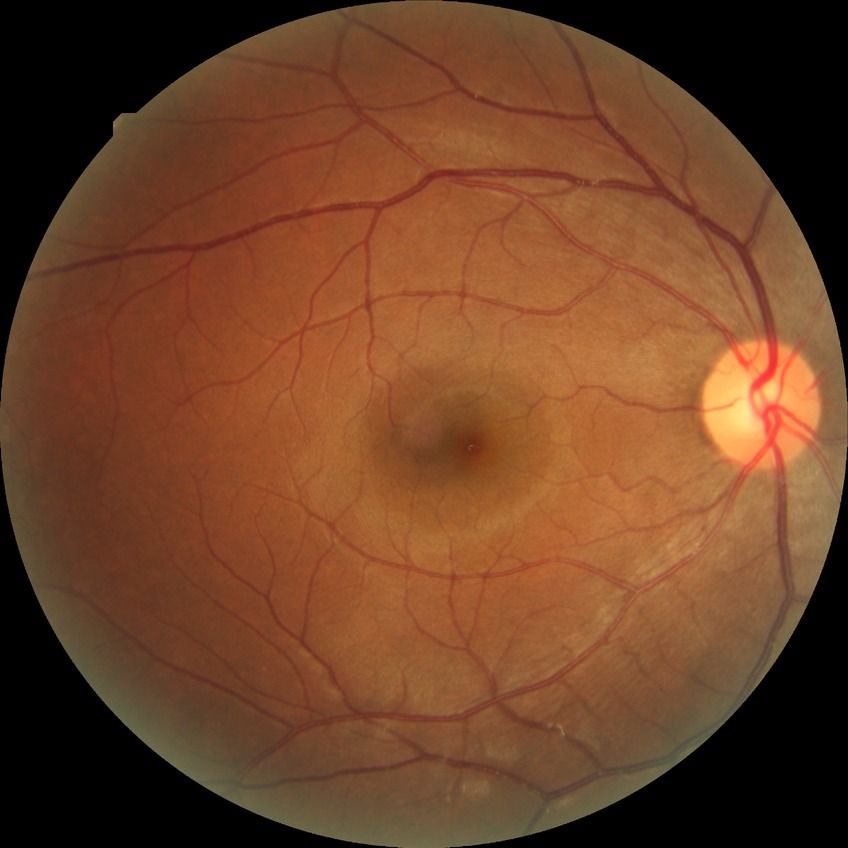

davis_grade: no diabetic retinopathy